Pachymetry 543 µm · patient age: 78 years · disc-centered field
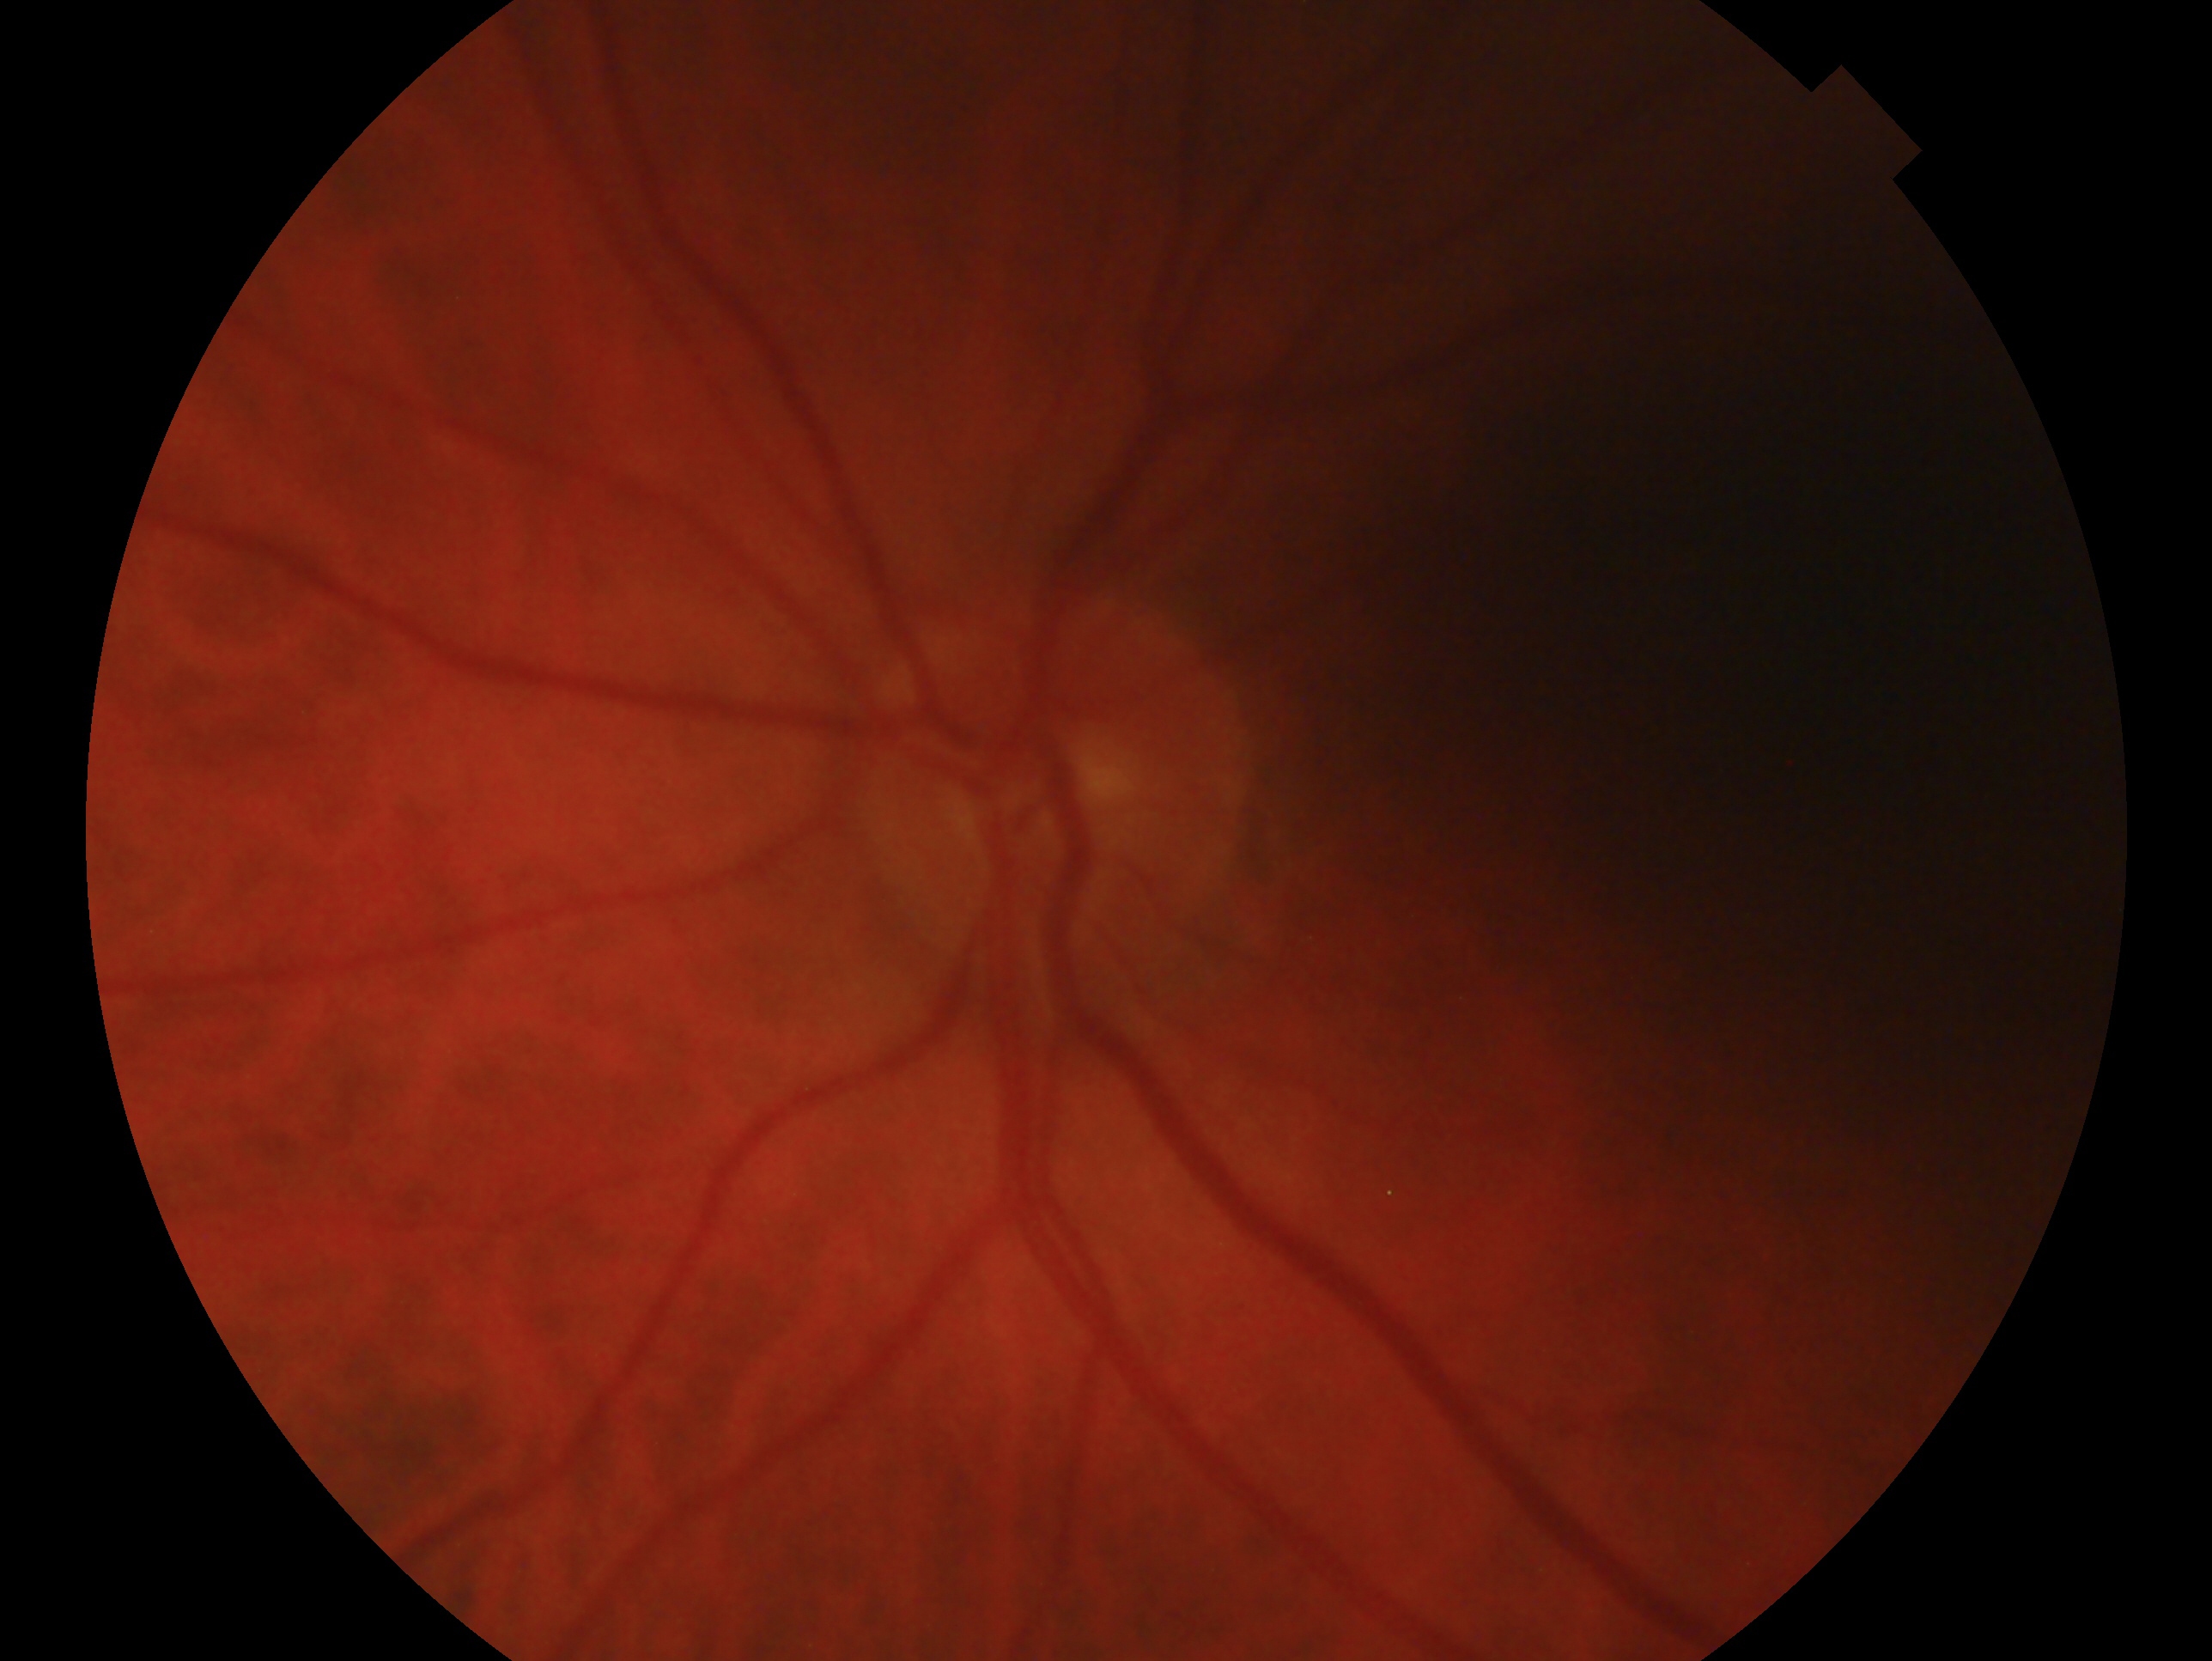

Q: Which eye is imaged?
A: left eye
Q: What is the glaucoma diagnosis?
A: no evidence of glaucoma